Wide-field fundus image from infant ROP screening. Image size 640x480.
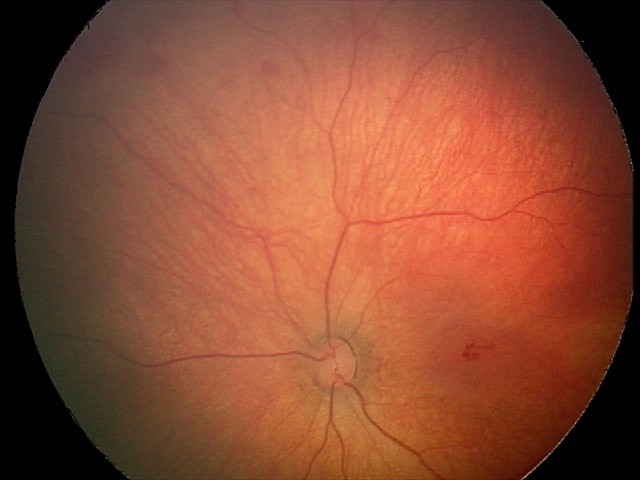

Screening series with retinal hemorrhages.